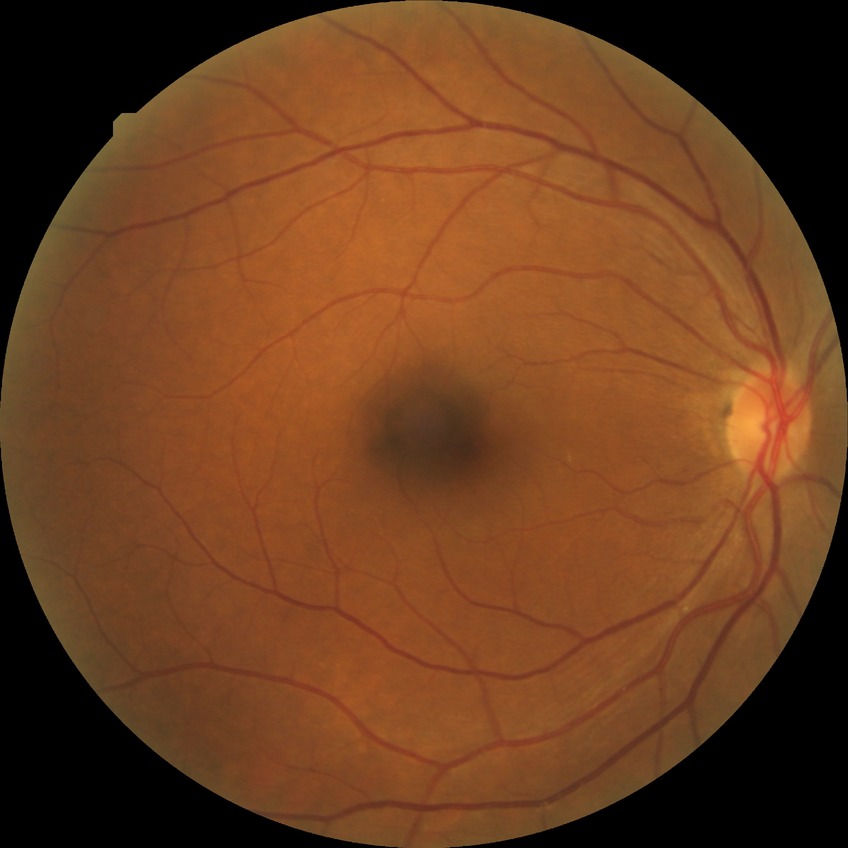

{
  "davis_grade": "NDR"
}